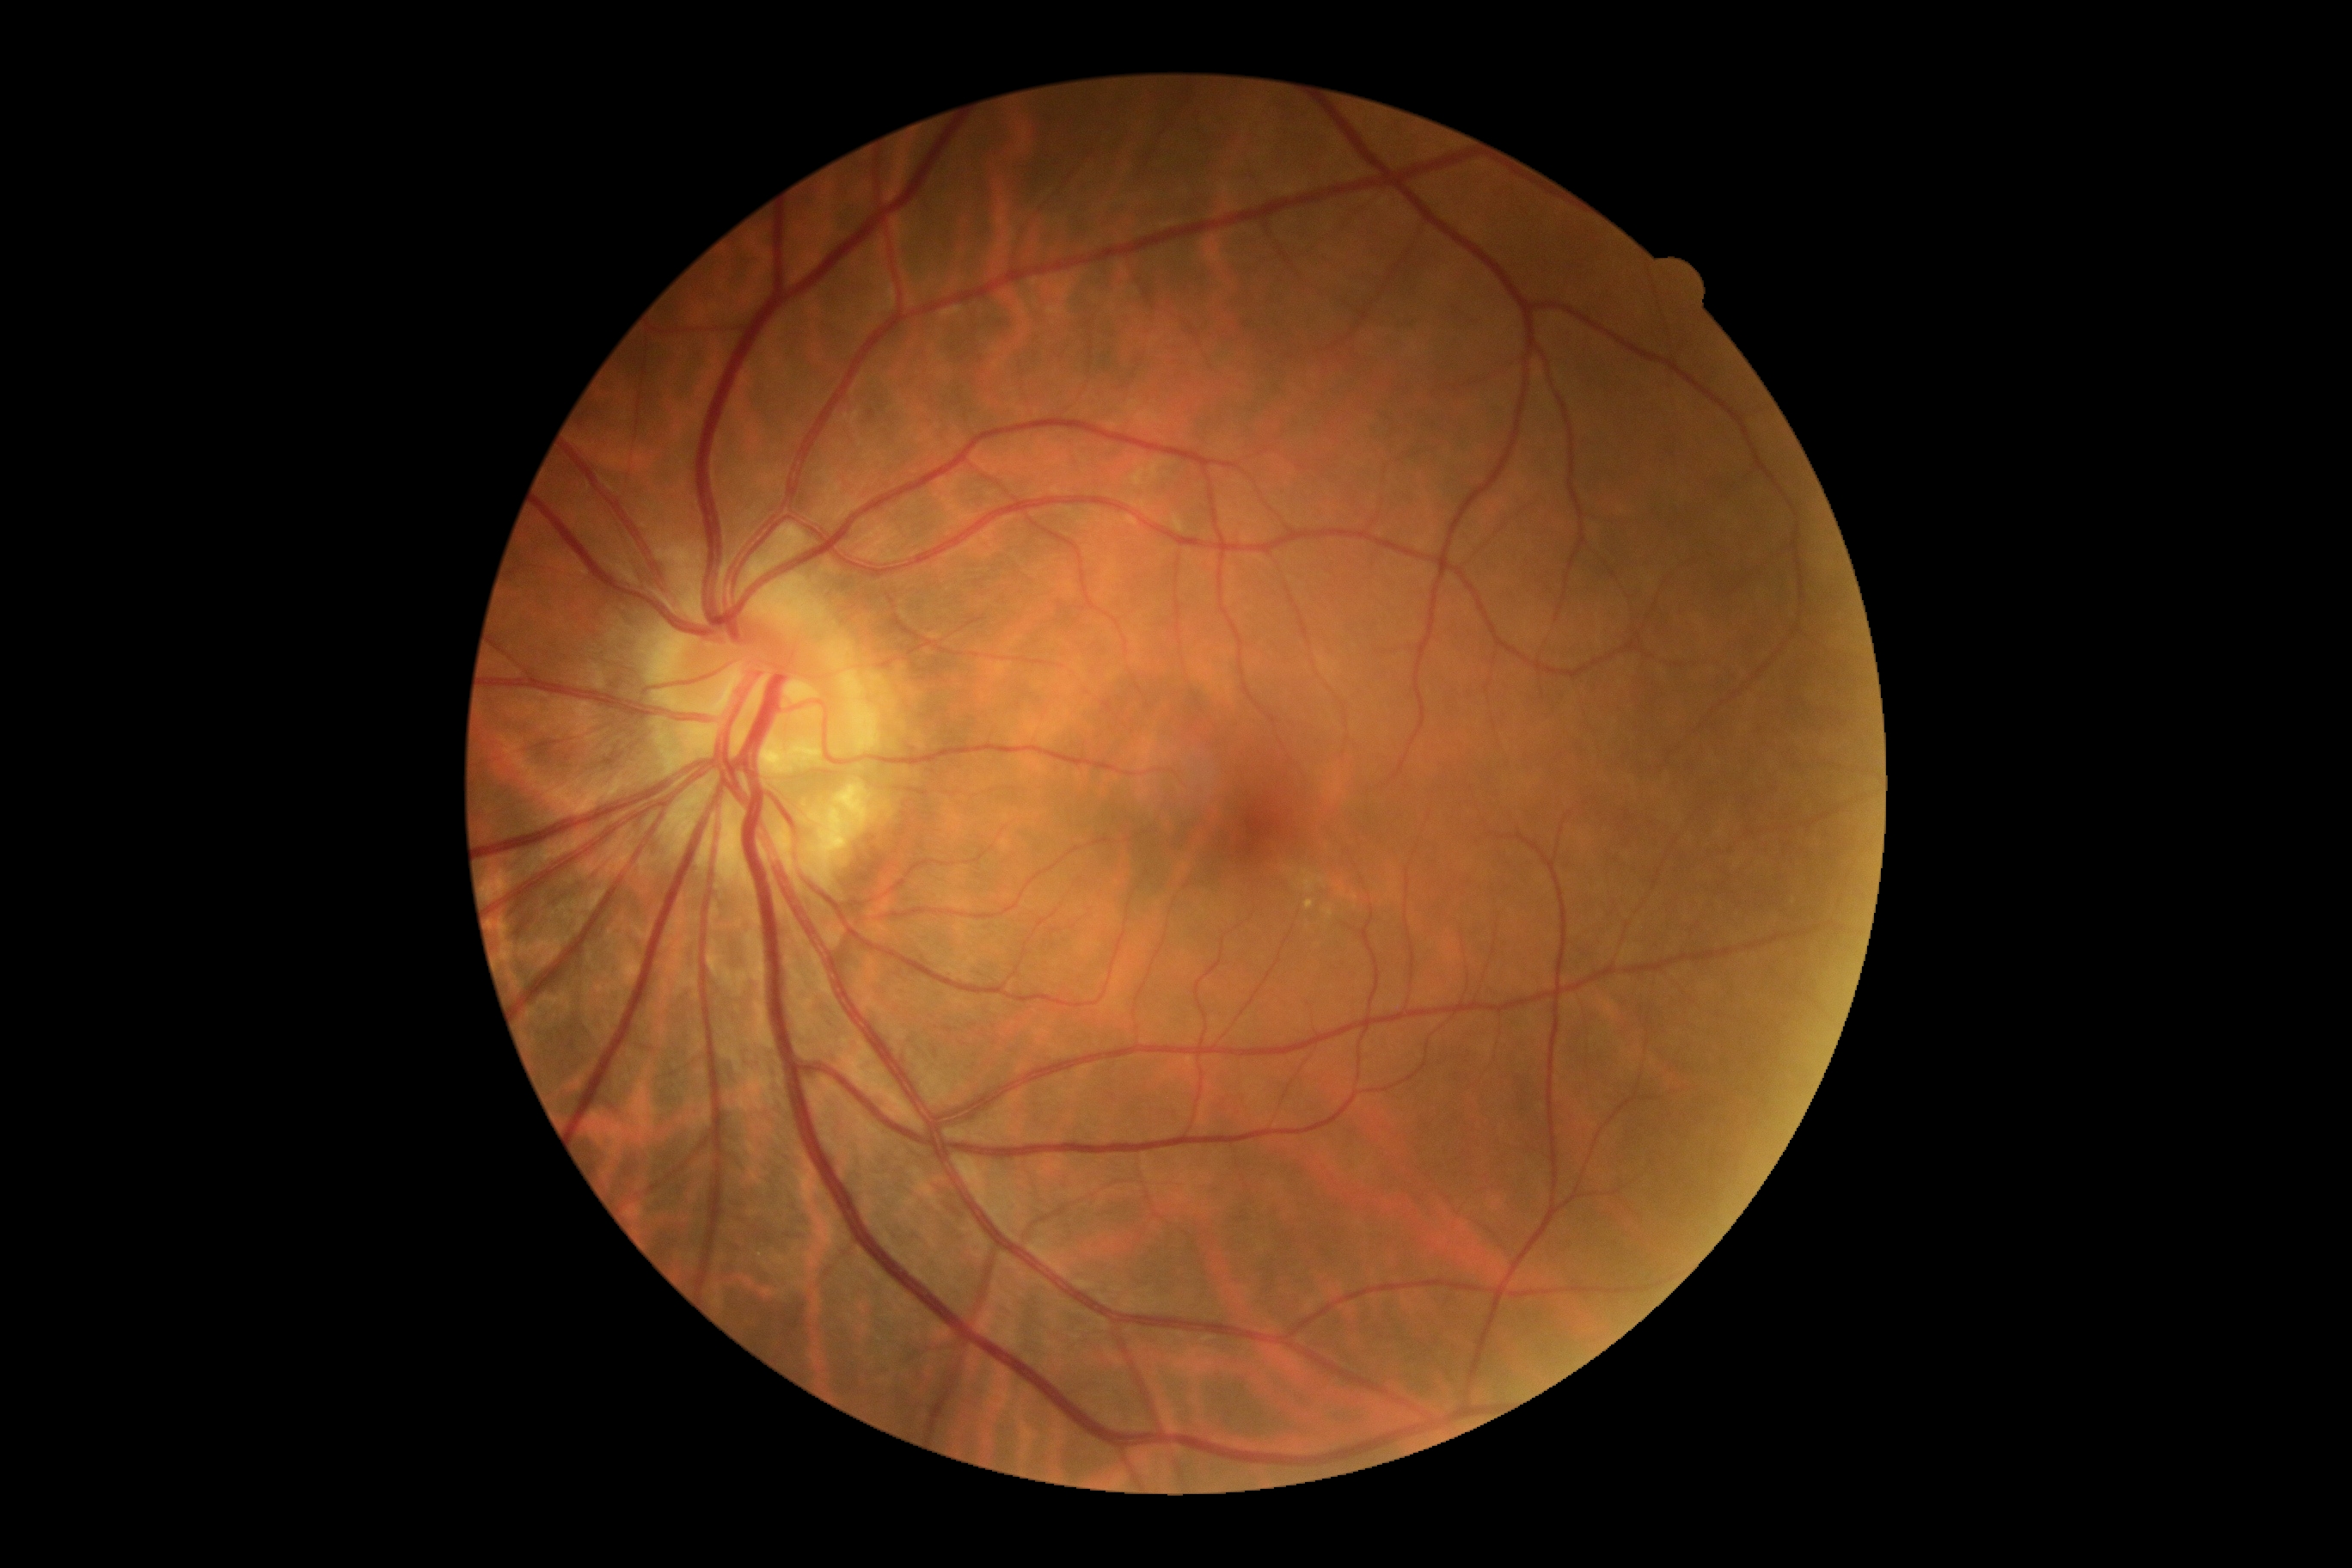 Annotations:
- DR stage: grade 0